FOV: 50 degrees; 2361 by 1568 pixels; macula-centered field; captured after pupil dilation
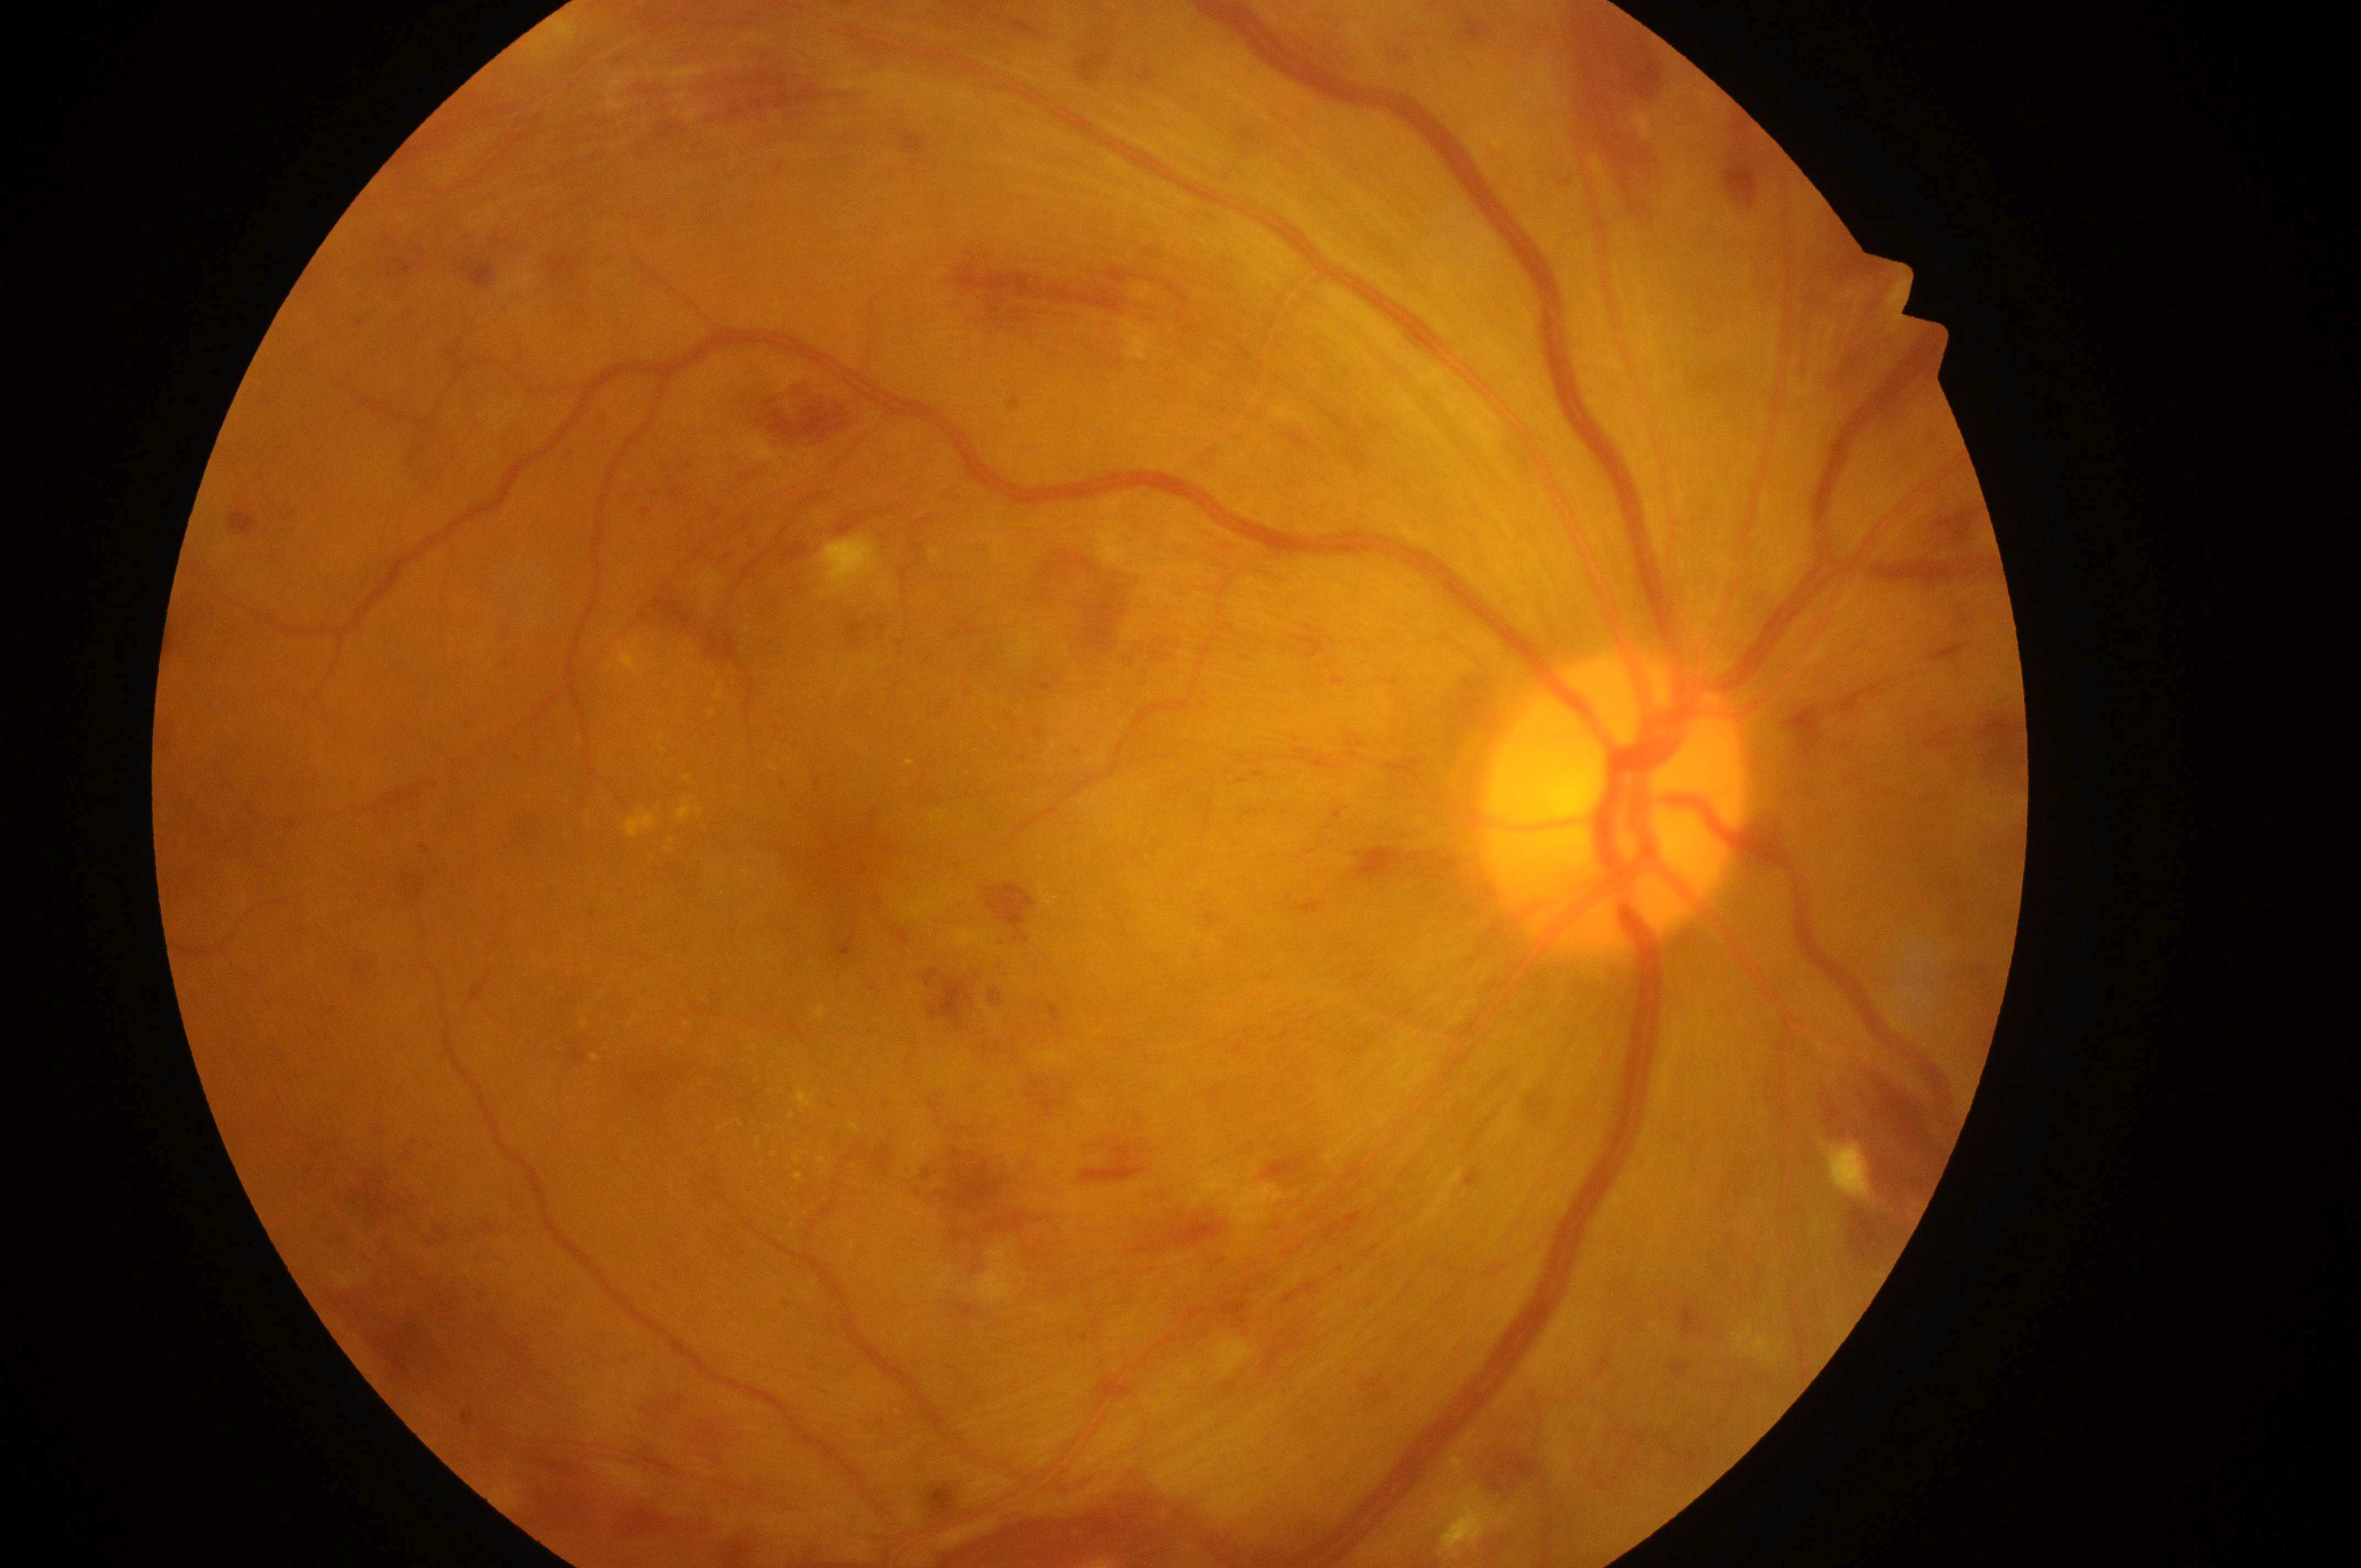
Diabetic retinopathy: severe NPDR (grade 3) — more than 20 intraretinal hemorrhages in each of 4 quadrants, definite venous beading in 2 or more quadrants, or prominent intraretinal microvascular abnormalities in 1 or more quadrants, with no signs of proliferative retinopathy. Fovea: (x=850, y=866). Optic nerve head located at (x=1609, y=814). The retinopathy is classified as non-proliferative diabetic retinopathy. Risk of macular edema is grade 2 (high risk) — hard exudates within one disc diameter of the macula center. Eye: OD.